Forus 3Nethra Classic fundus camera
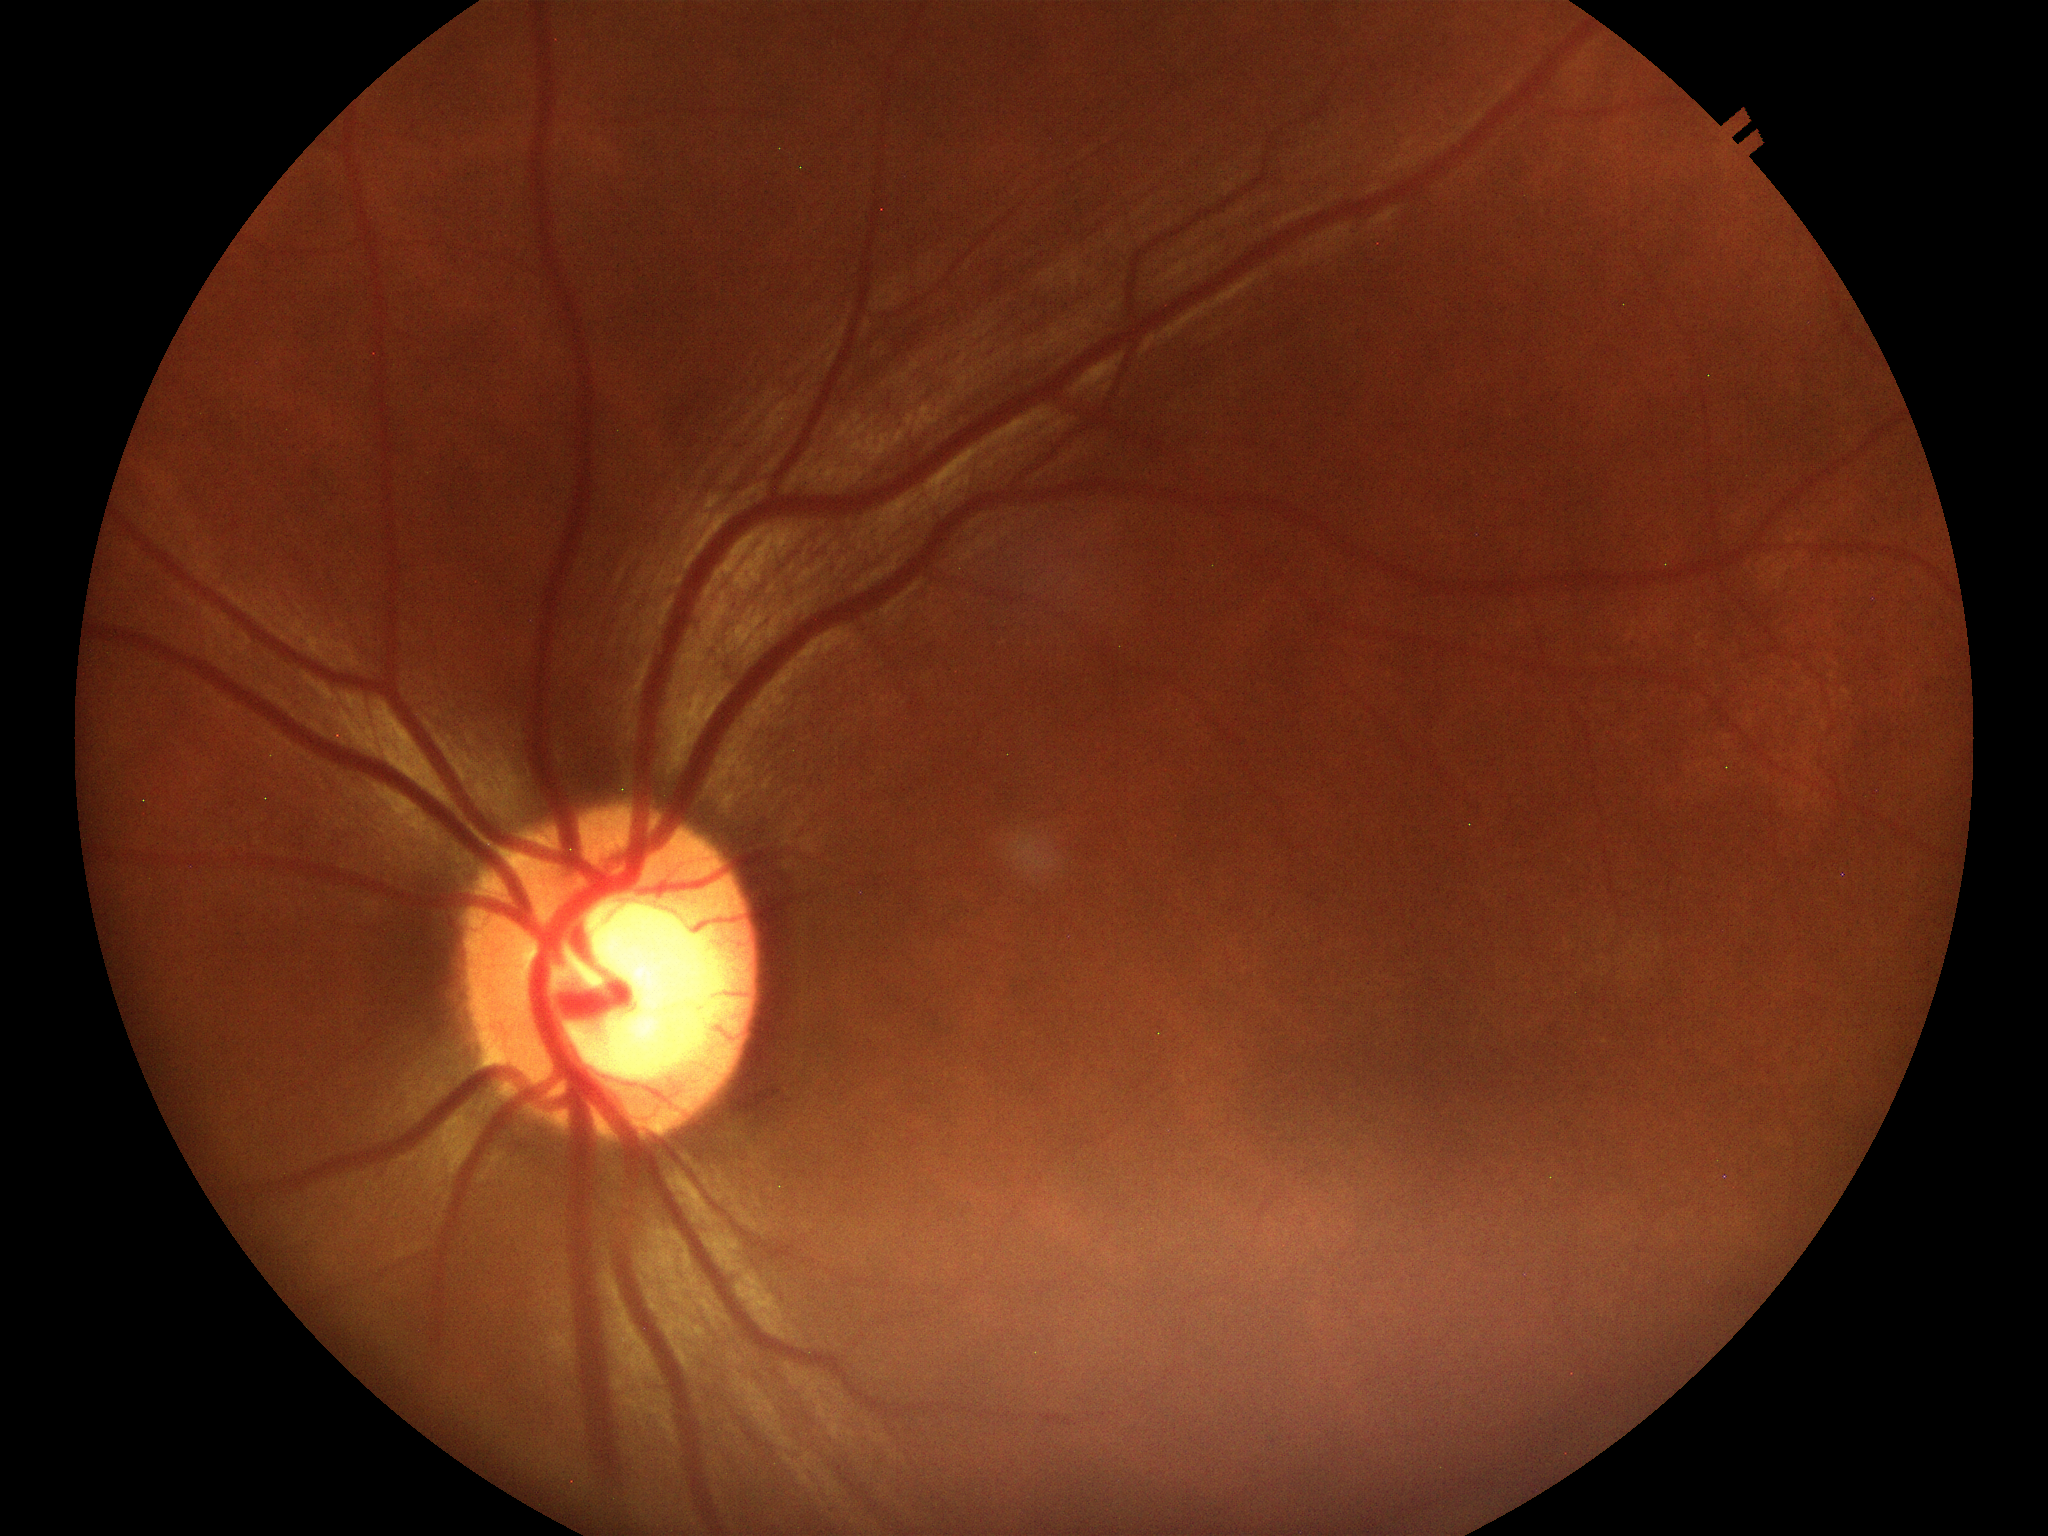

Vertical C/D ratio (VCDR) of 0.58.
Suspicious for glaucoma.